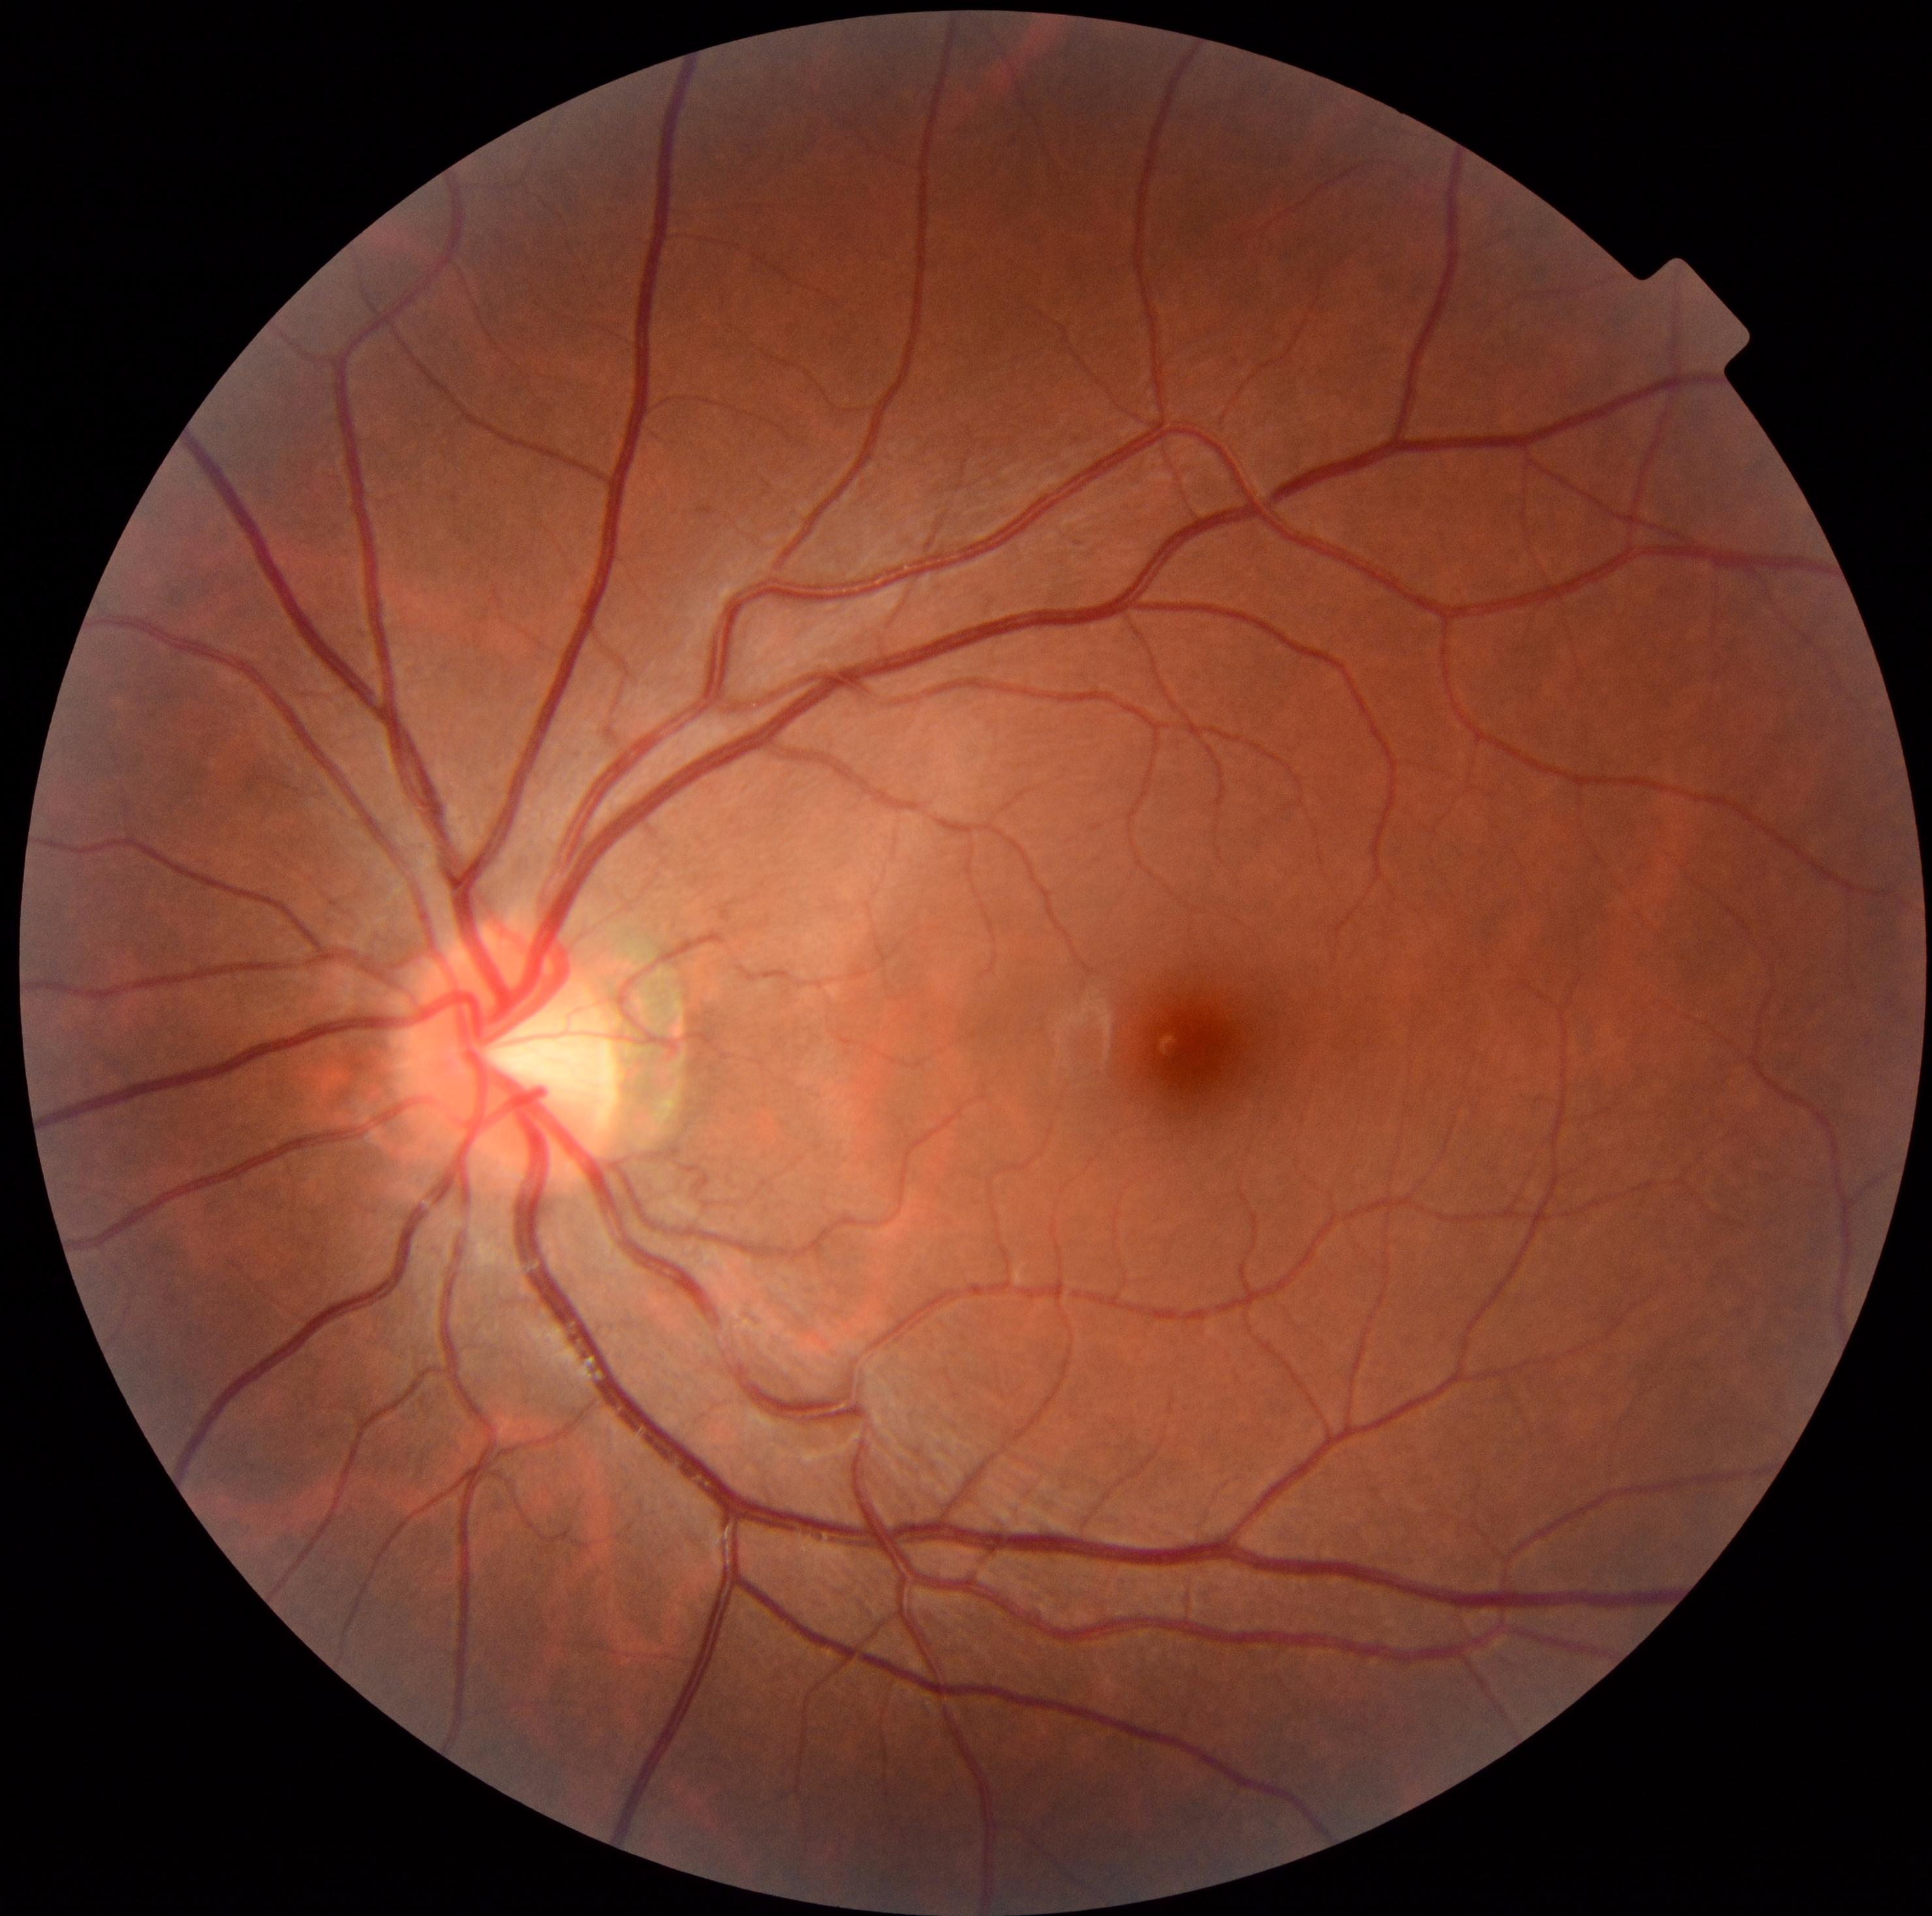 Diabetic retinopathy (DR) is grade 0 (no apparent retinopathy).